Pediatric retinal photograph (wide-field): 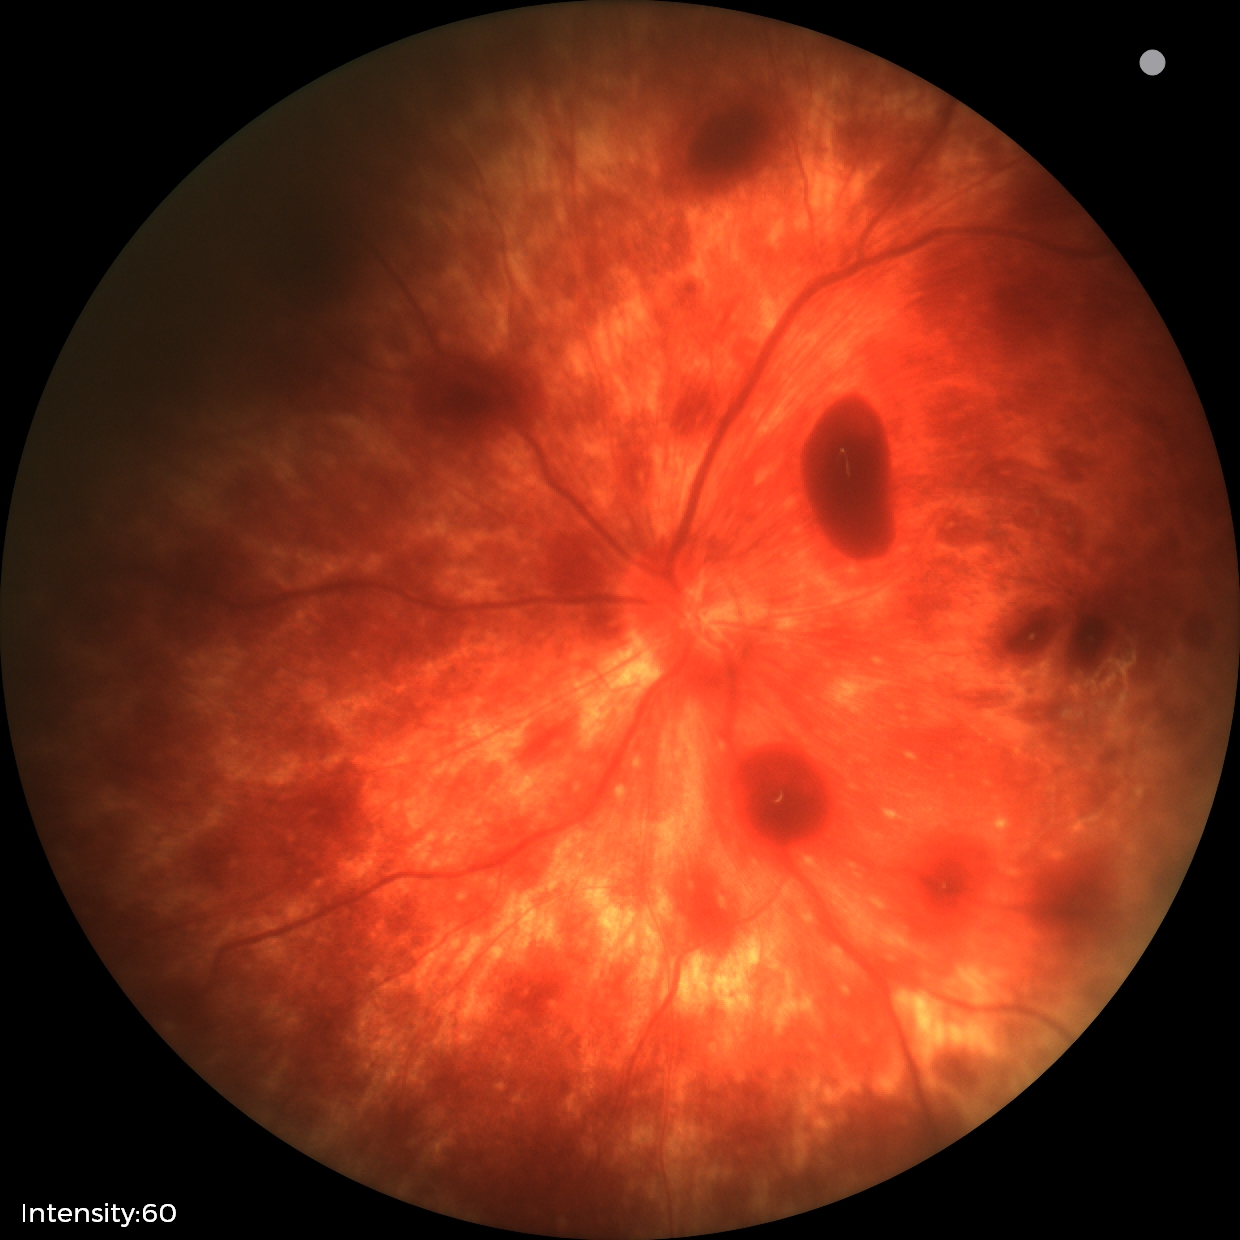
Diagnosis from this screening exam: retinal hemorrhages.